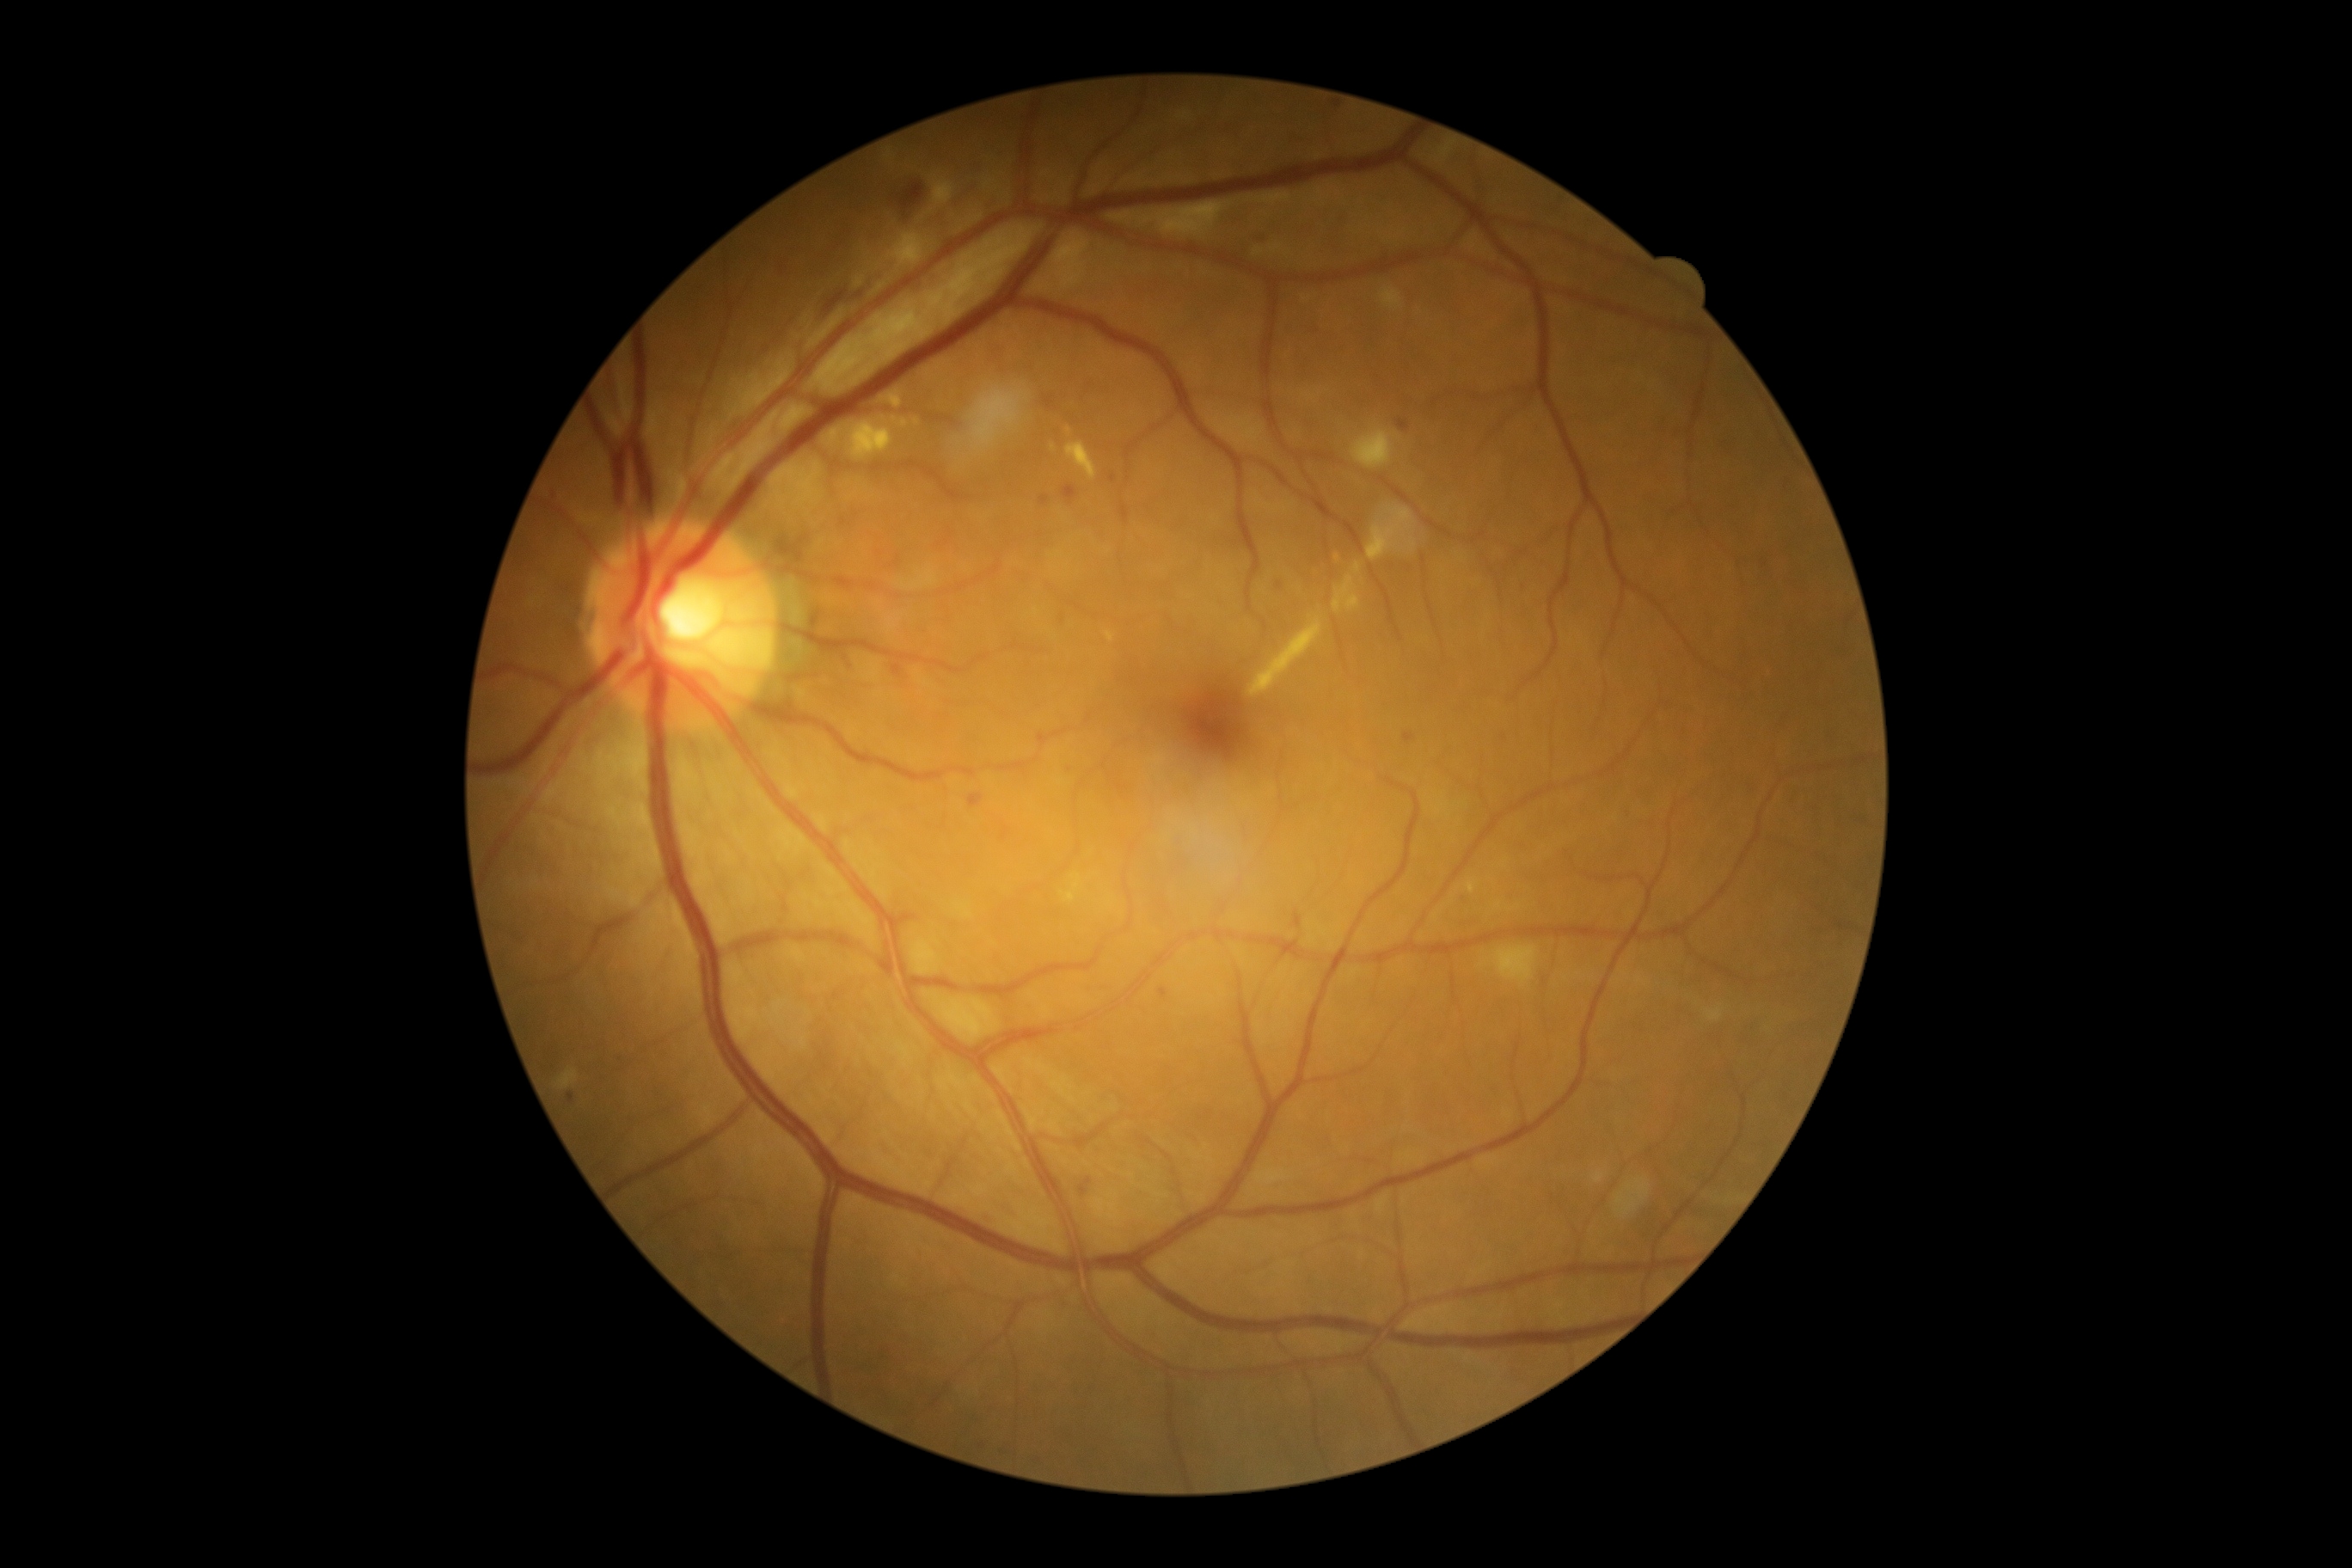
Diabetic retinopathy grade: moderate NPDR (2).